1240x1240. Wide-field fundus image from infant ROP screening
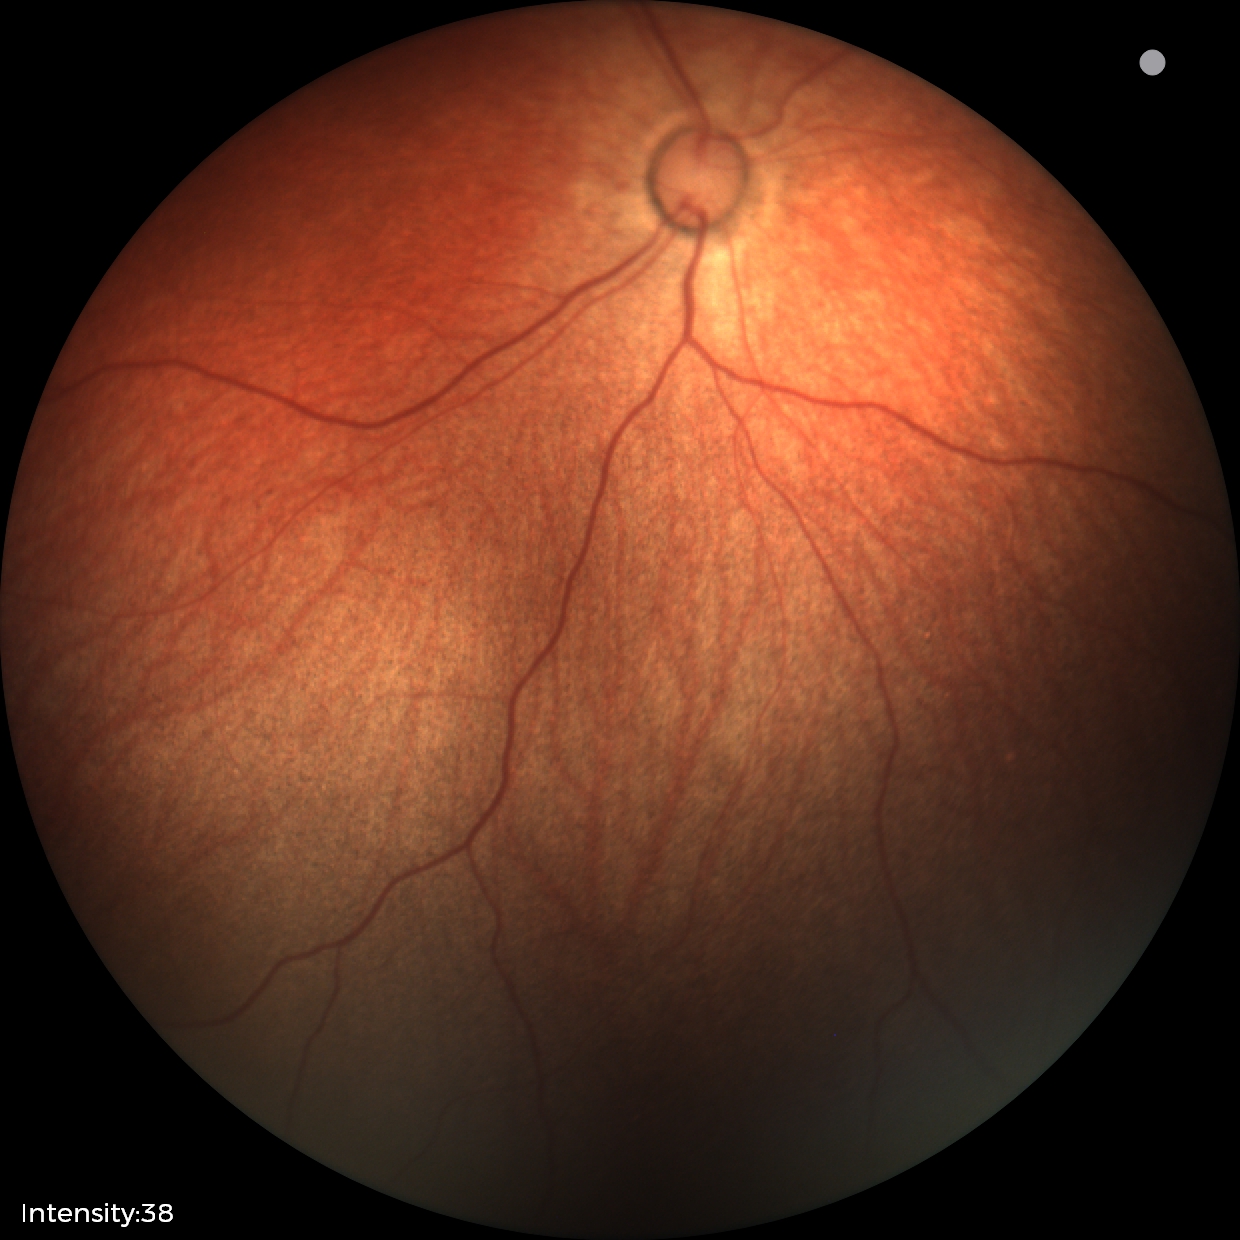

Normal screening examination.